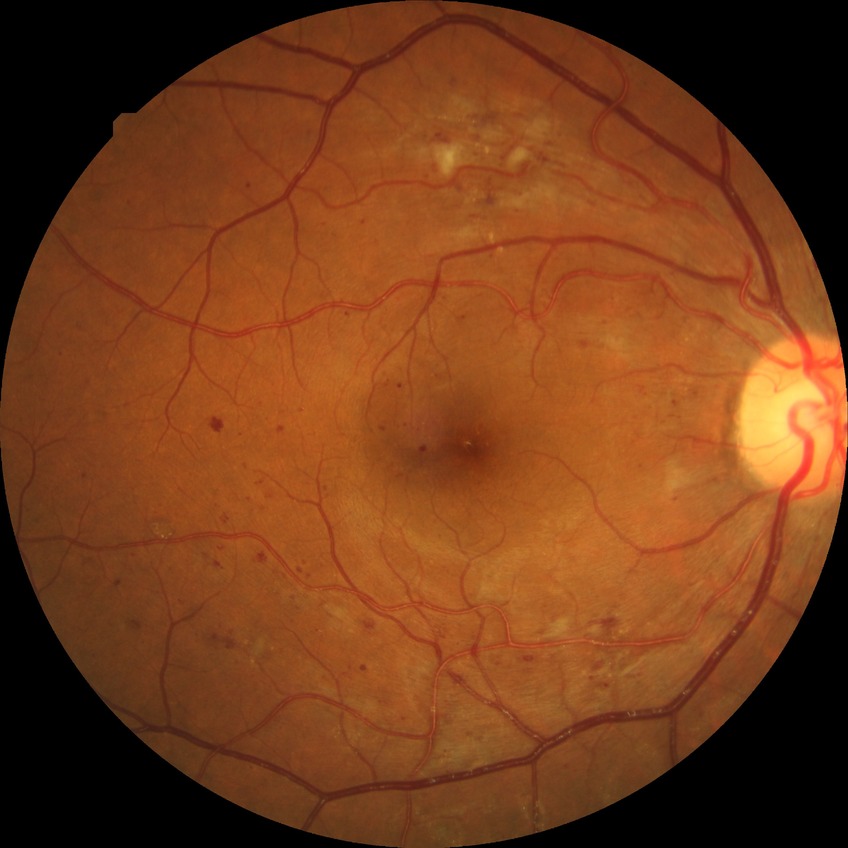
diabetic retinopathy severity@pre-proliferative diabetic retinopathy.